Phoenix ICON, 100° FOV; wide-field contact fundus photograph of an infant — 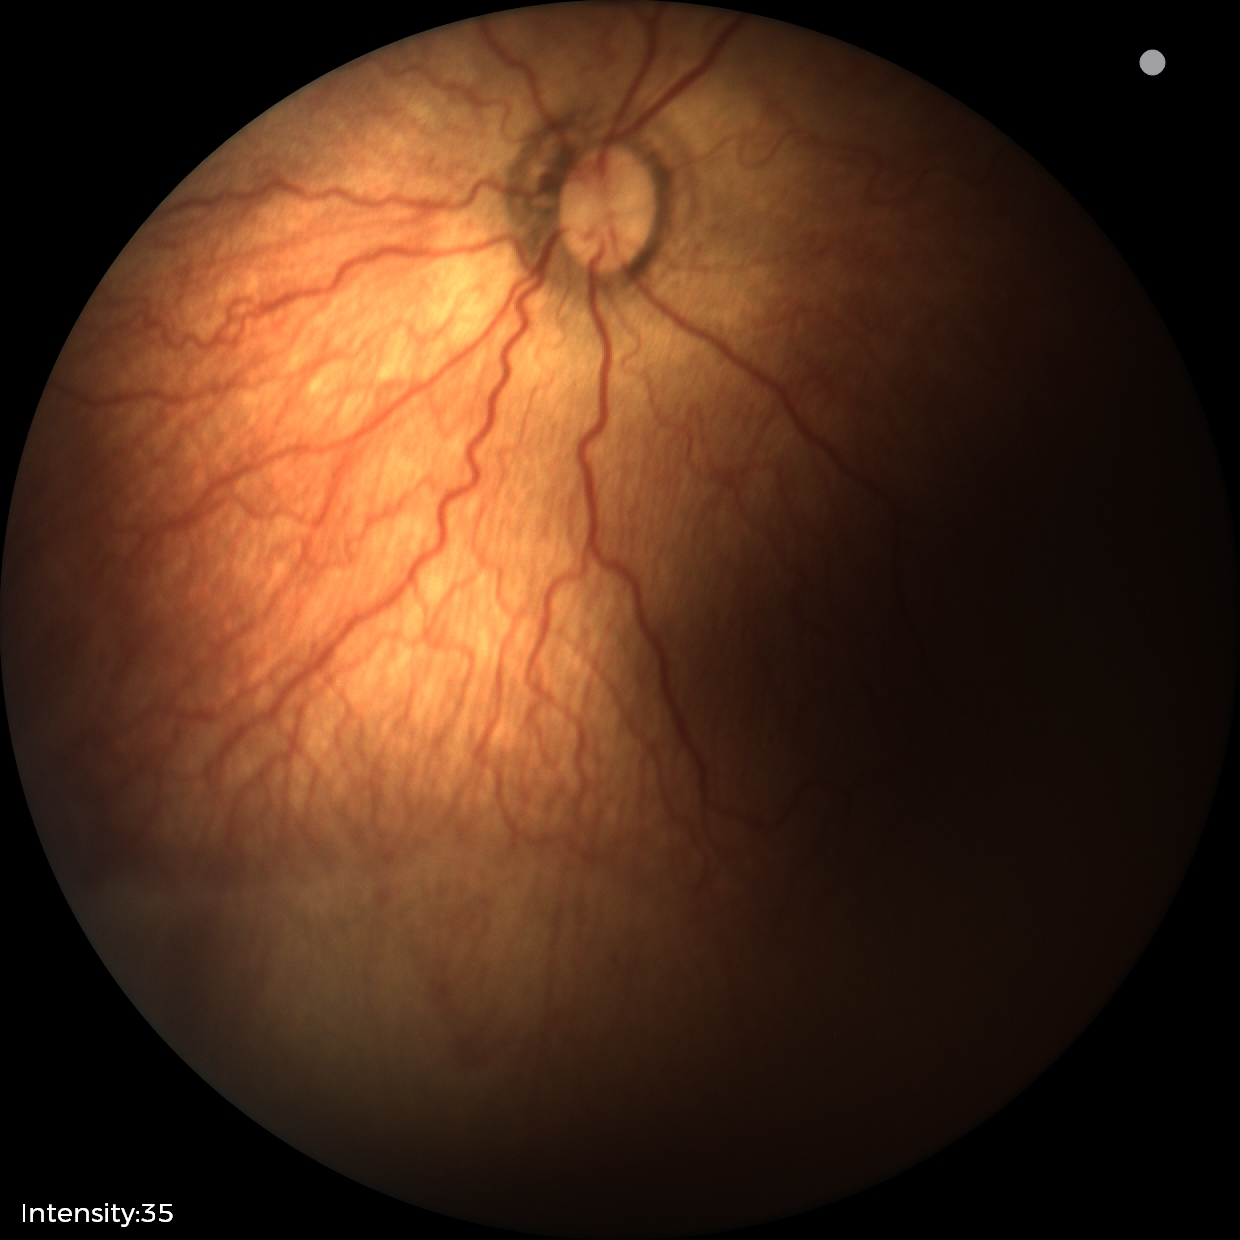
Screening examination consistent with ROP stage 2. Plus disease present.